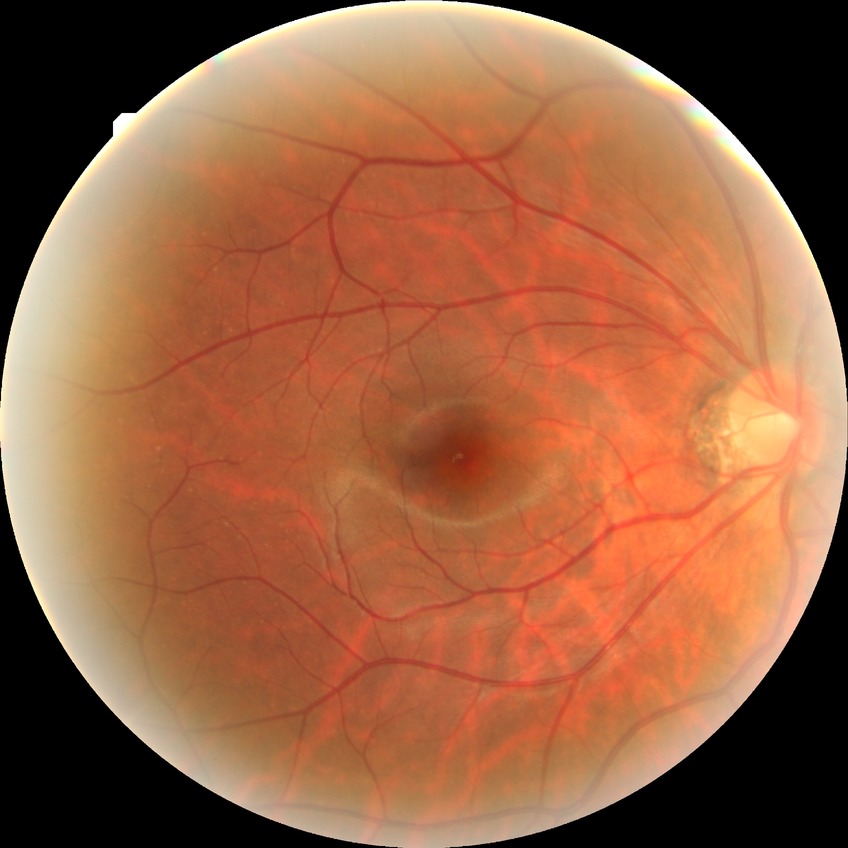 davis_grade: no diabetic retinopathy (NDR)